Image size 512x512
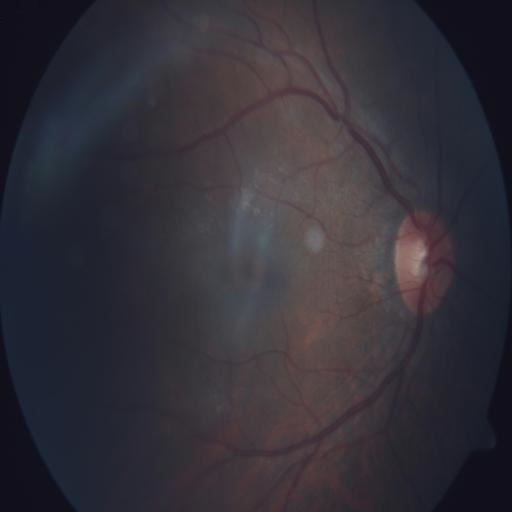 Fundus appearance consistent with tilted disc.